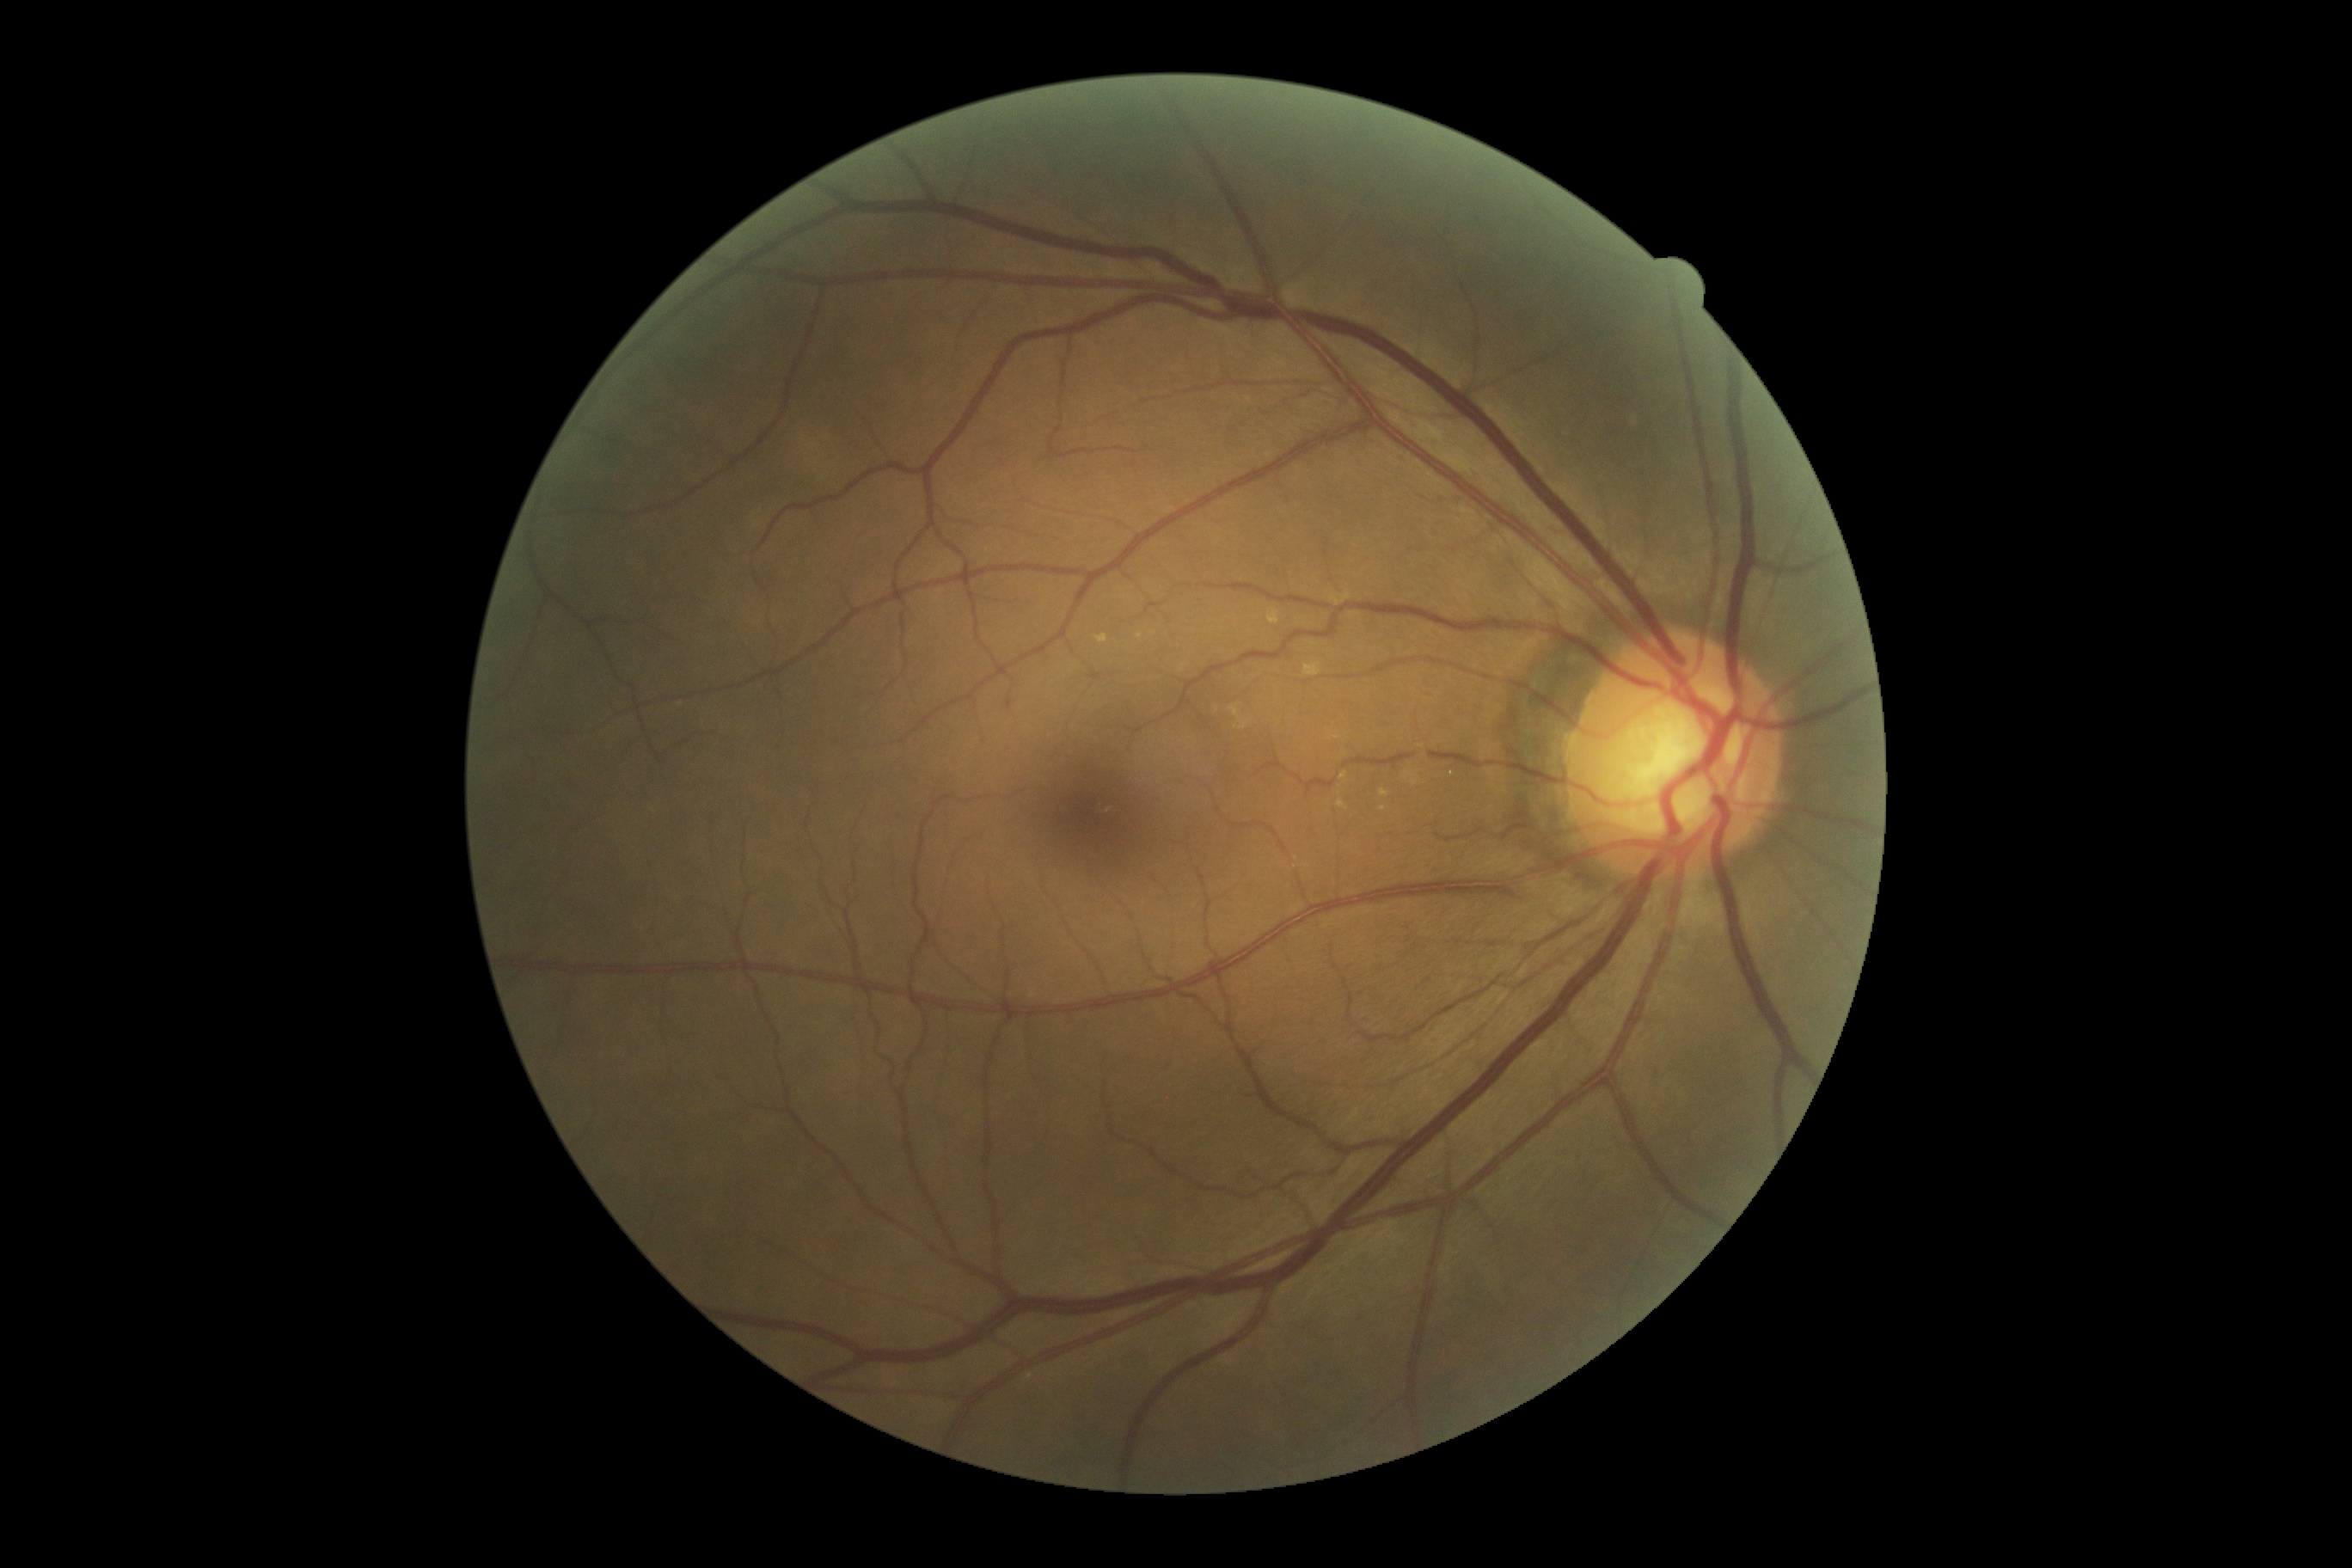 DR=no apparent retinopathy (grade 0).